Optic disc-centered crop from a color fundus photograph; 35° field of view before cropping — 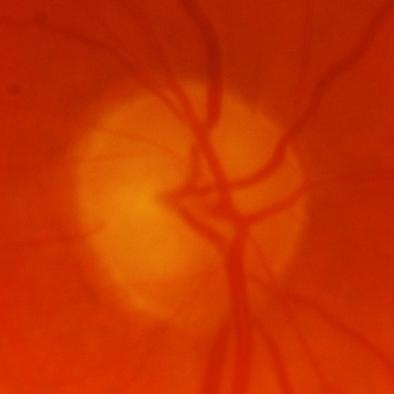 Assessment = evidence of glaucoma.